Wide-field contact fundus photograph of an infant. 1240x1240px — 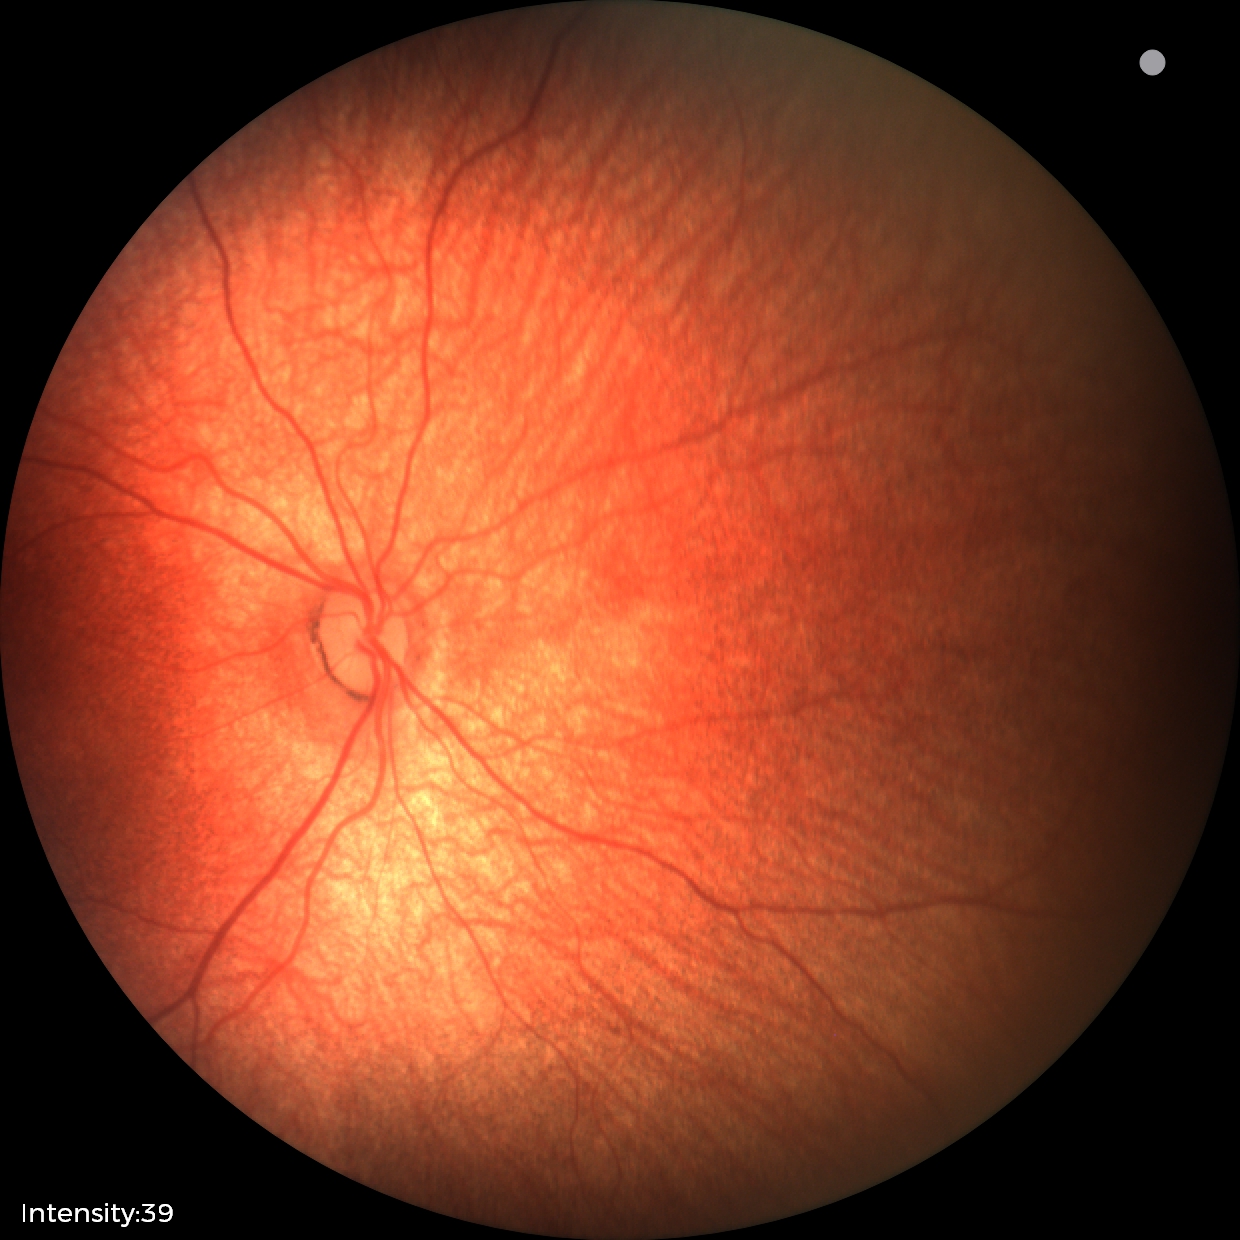 Screening examination diagnosed as physiological.